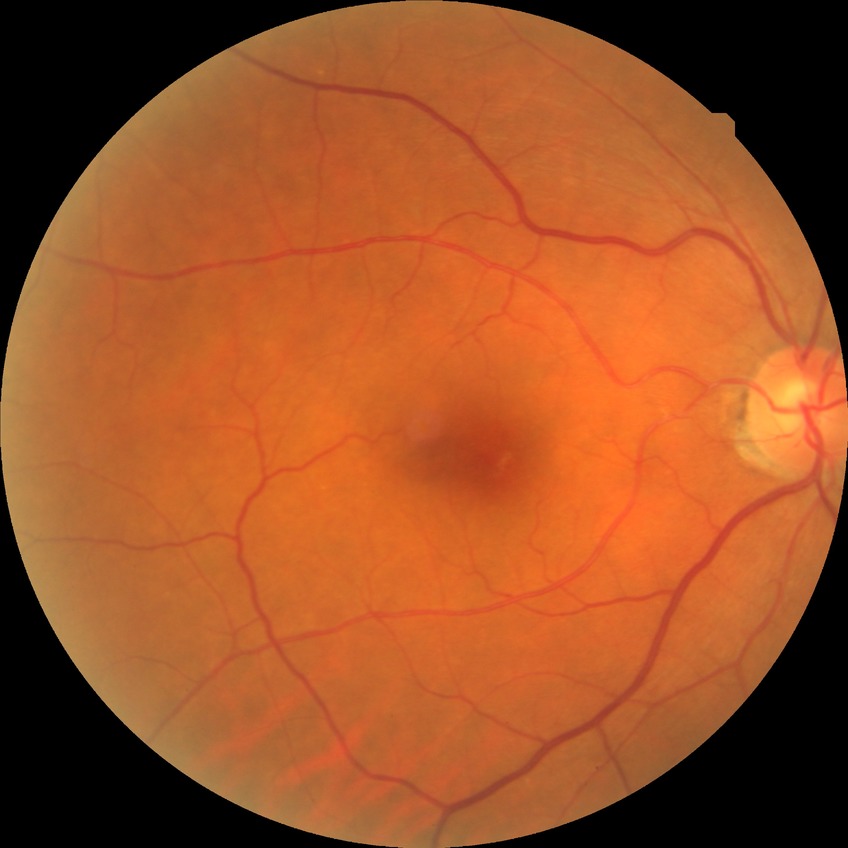

Diabetic retinopathy (DR) is no diabetic retinopathy (NDR).